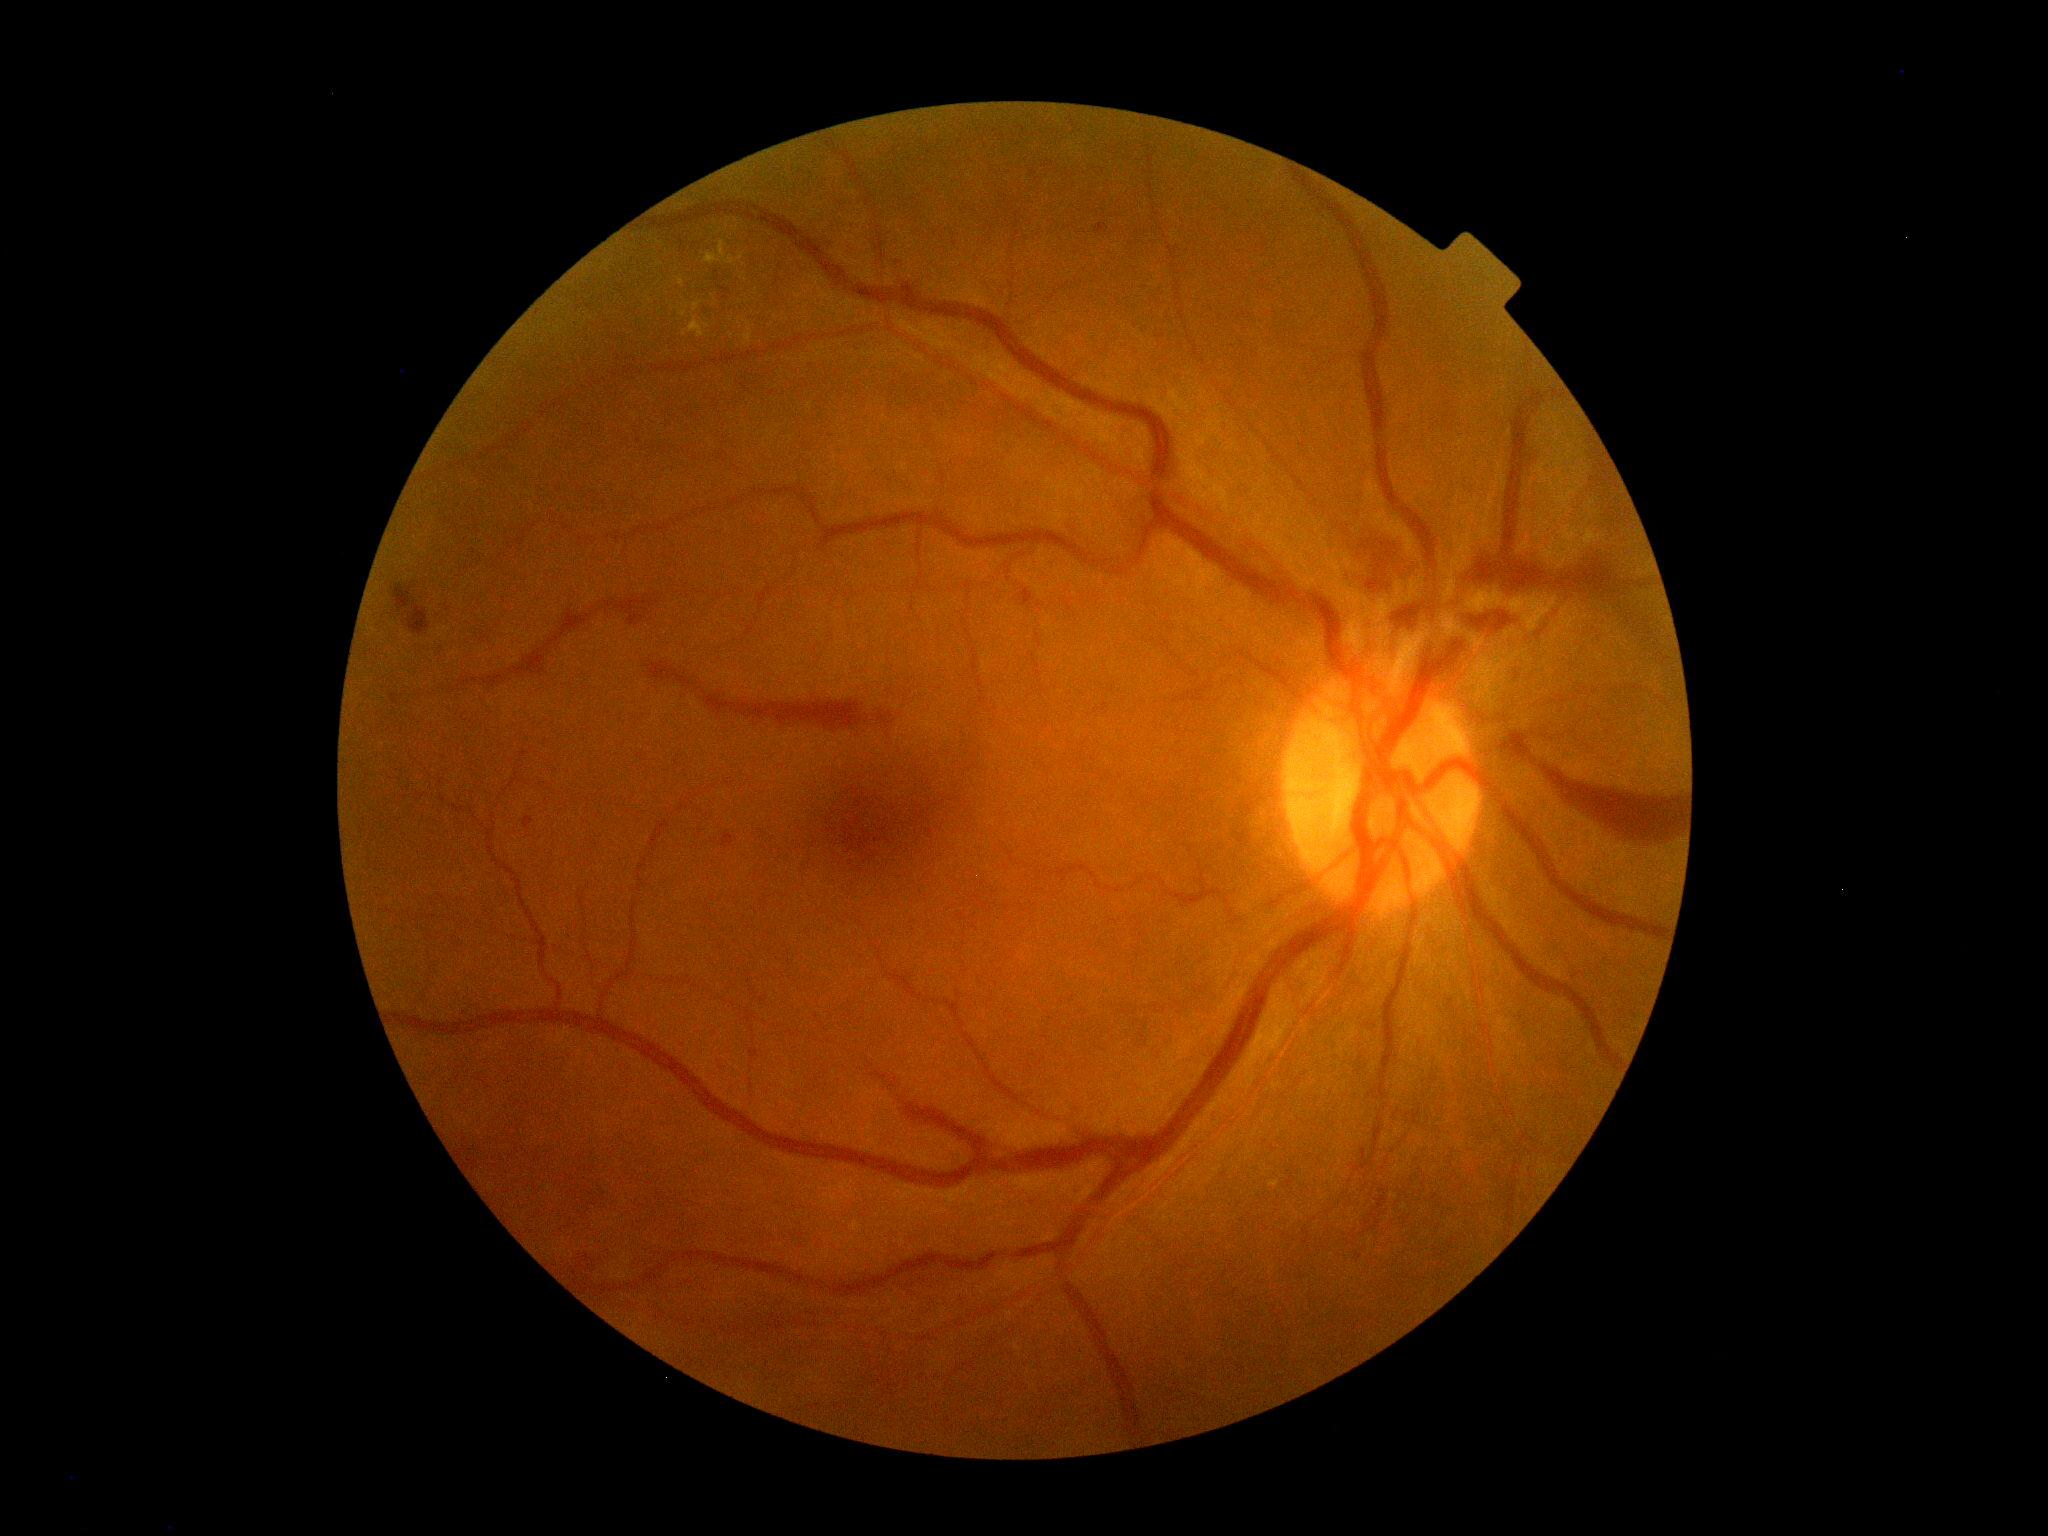

Diabetic retinopathy (DR): grade 4 (PDR).